CFP.
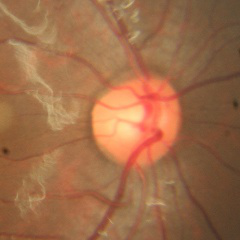

Findings consistent with no evidence of glaucoma.